45-degree field of view. Posterior pole photograph.
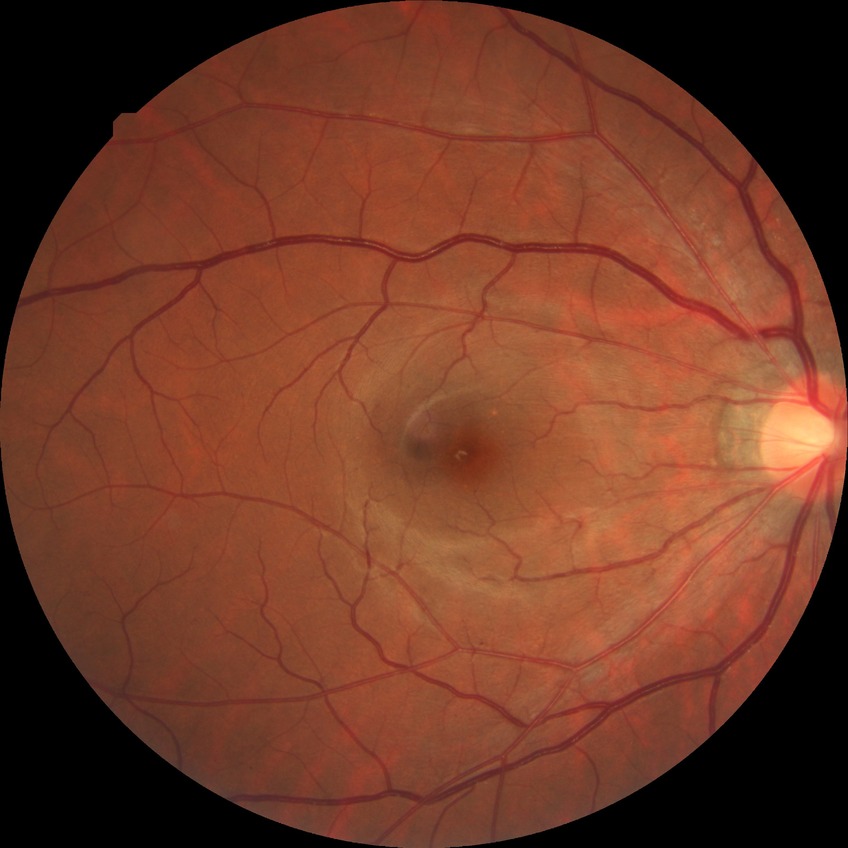

Diabetic retinopathy (DR) is NDR (no diabetic retinopathy).